Macula-centered · image size 1932x1932 — 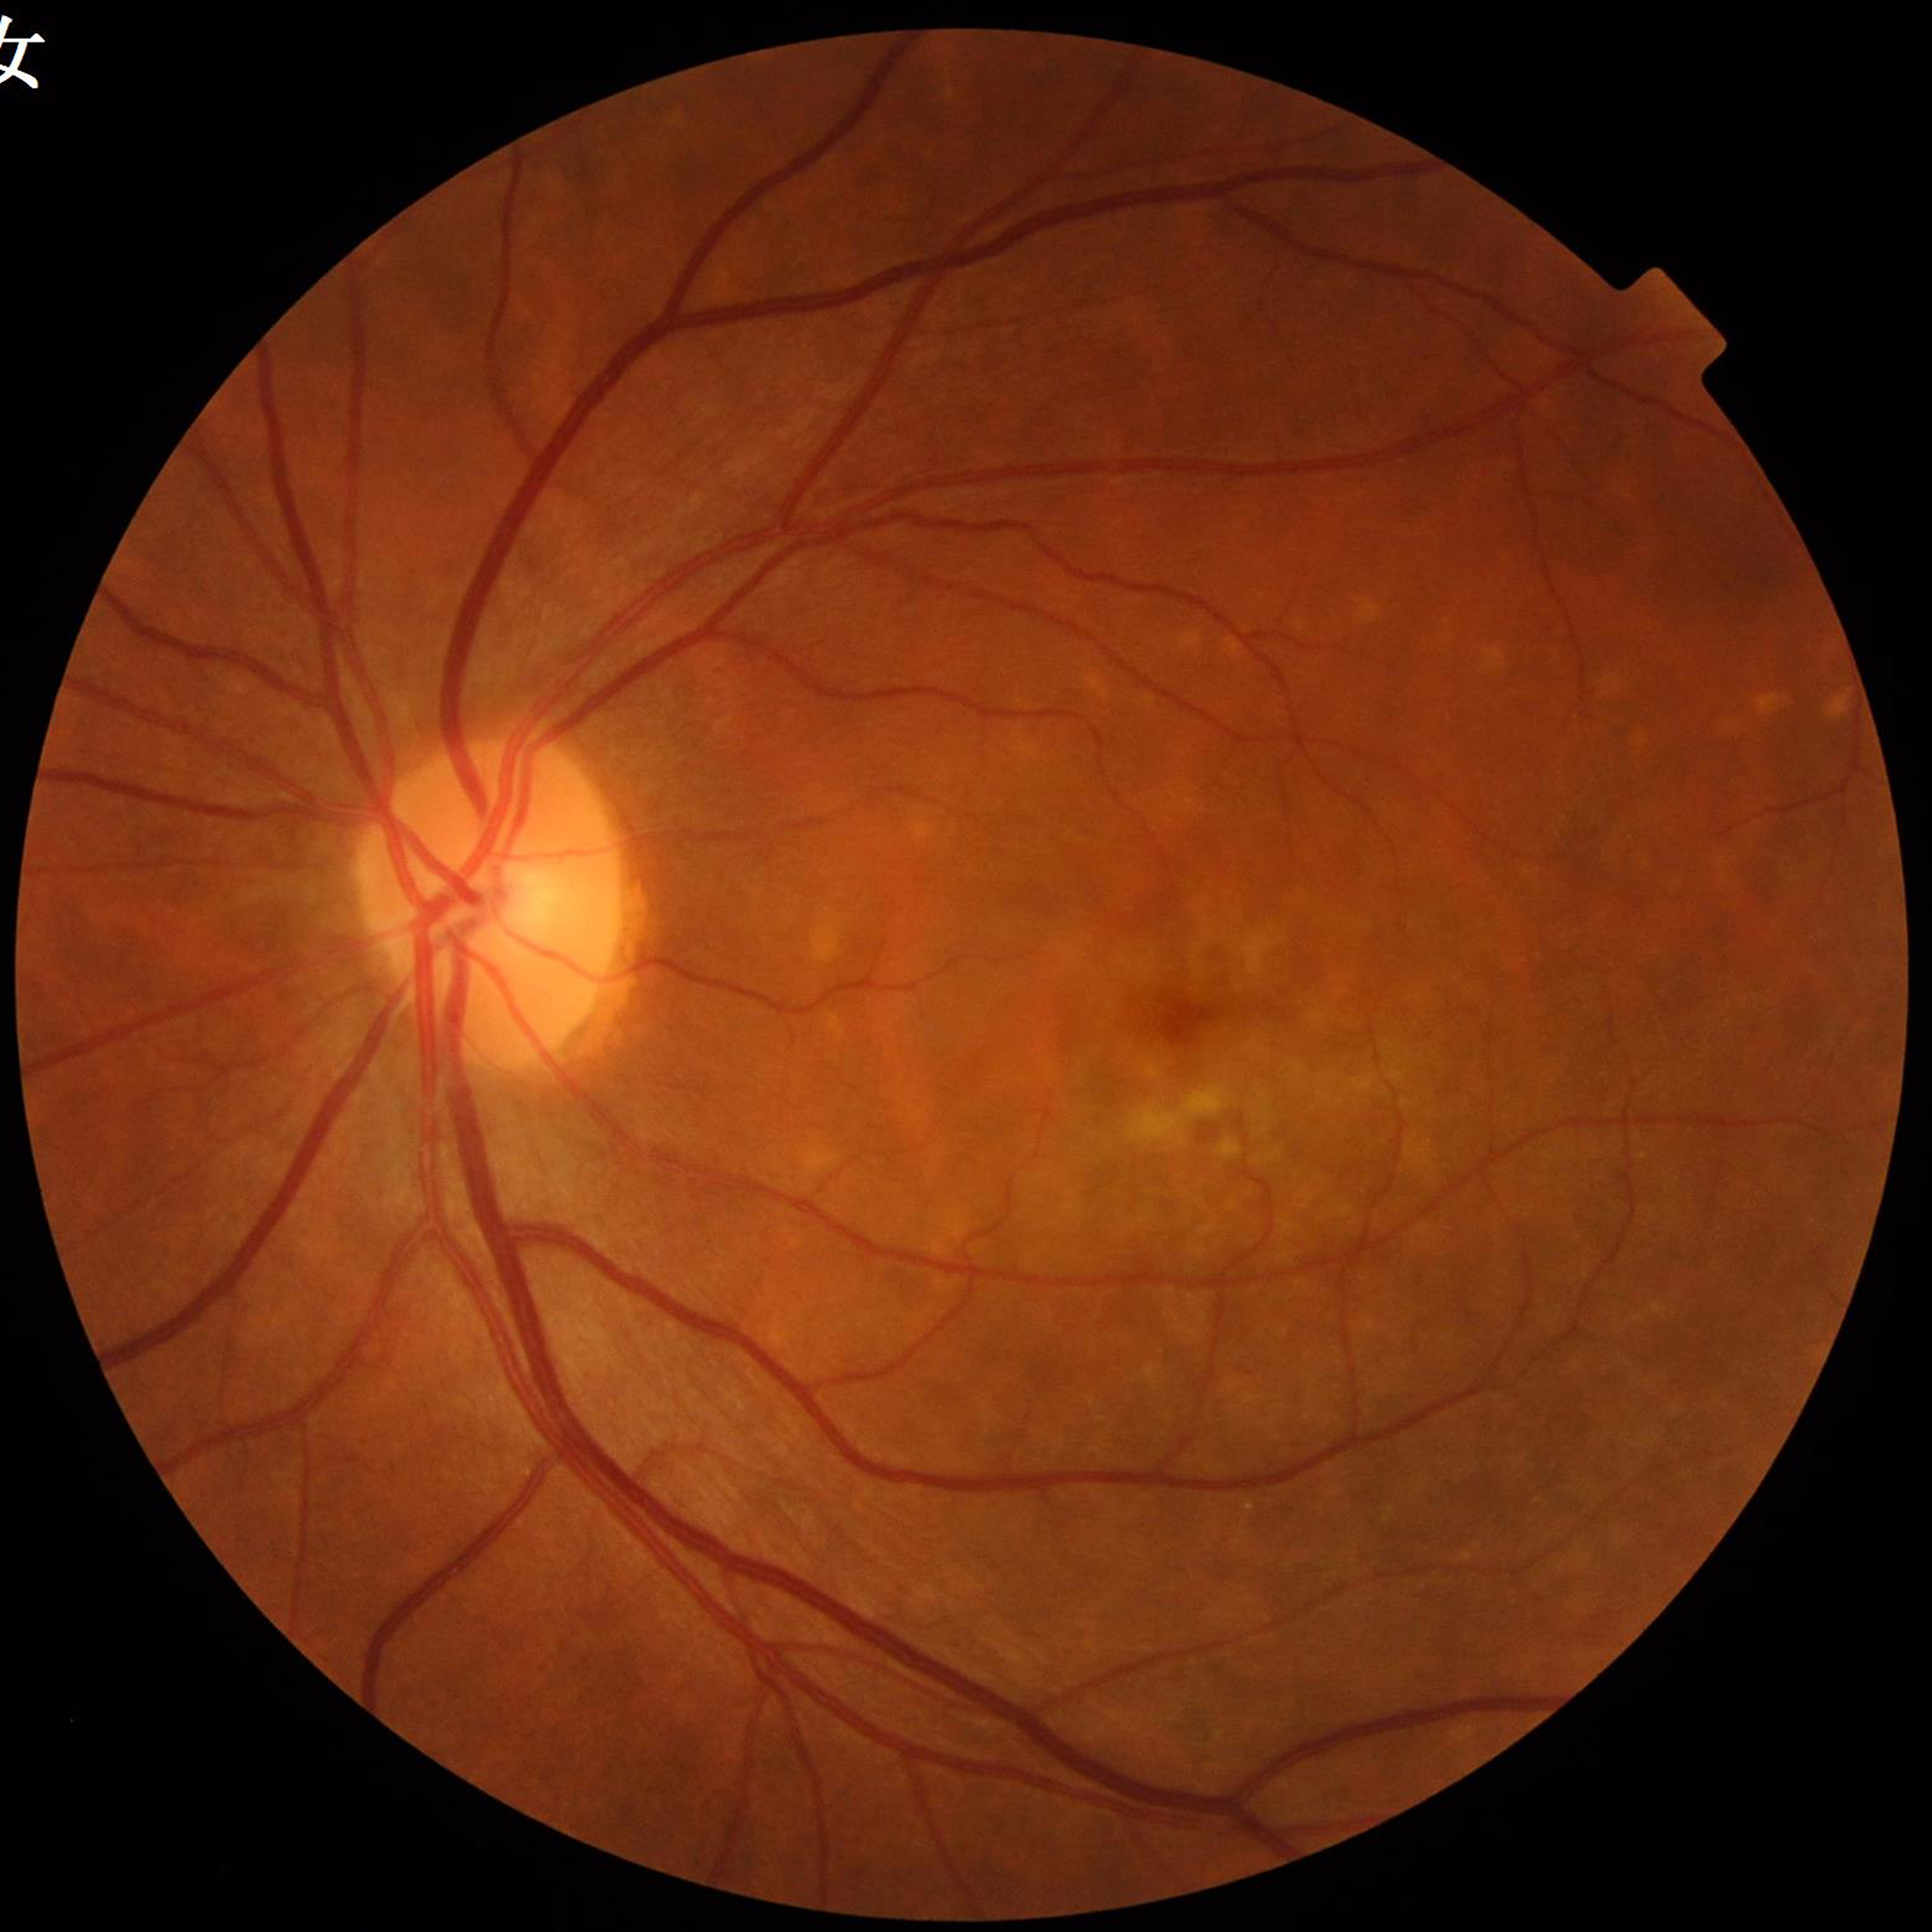

Condition: AMD.